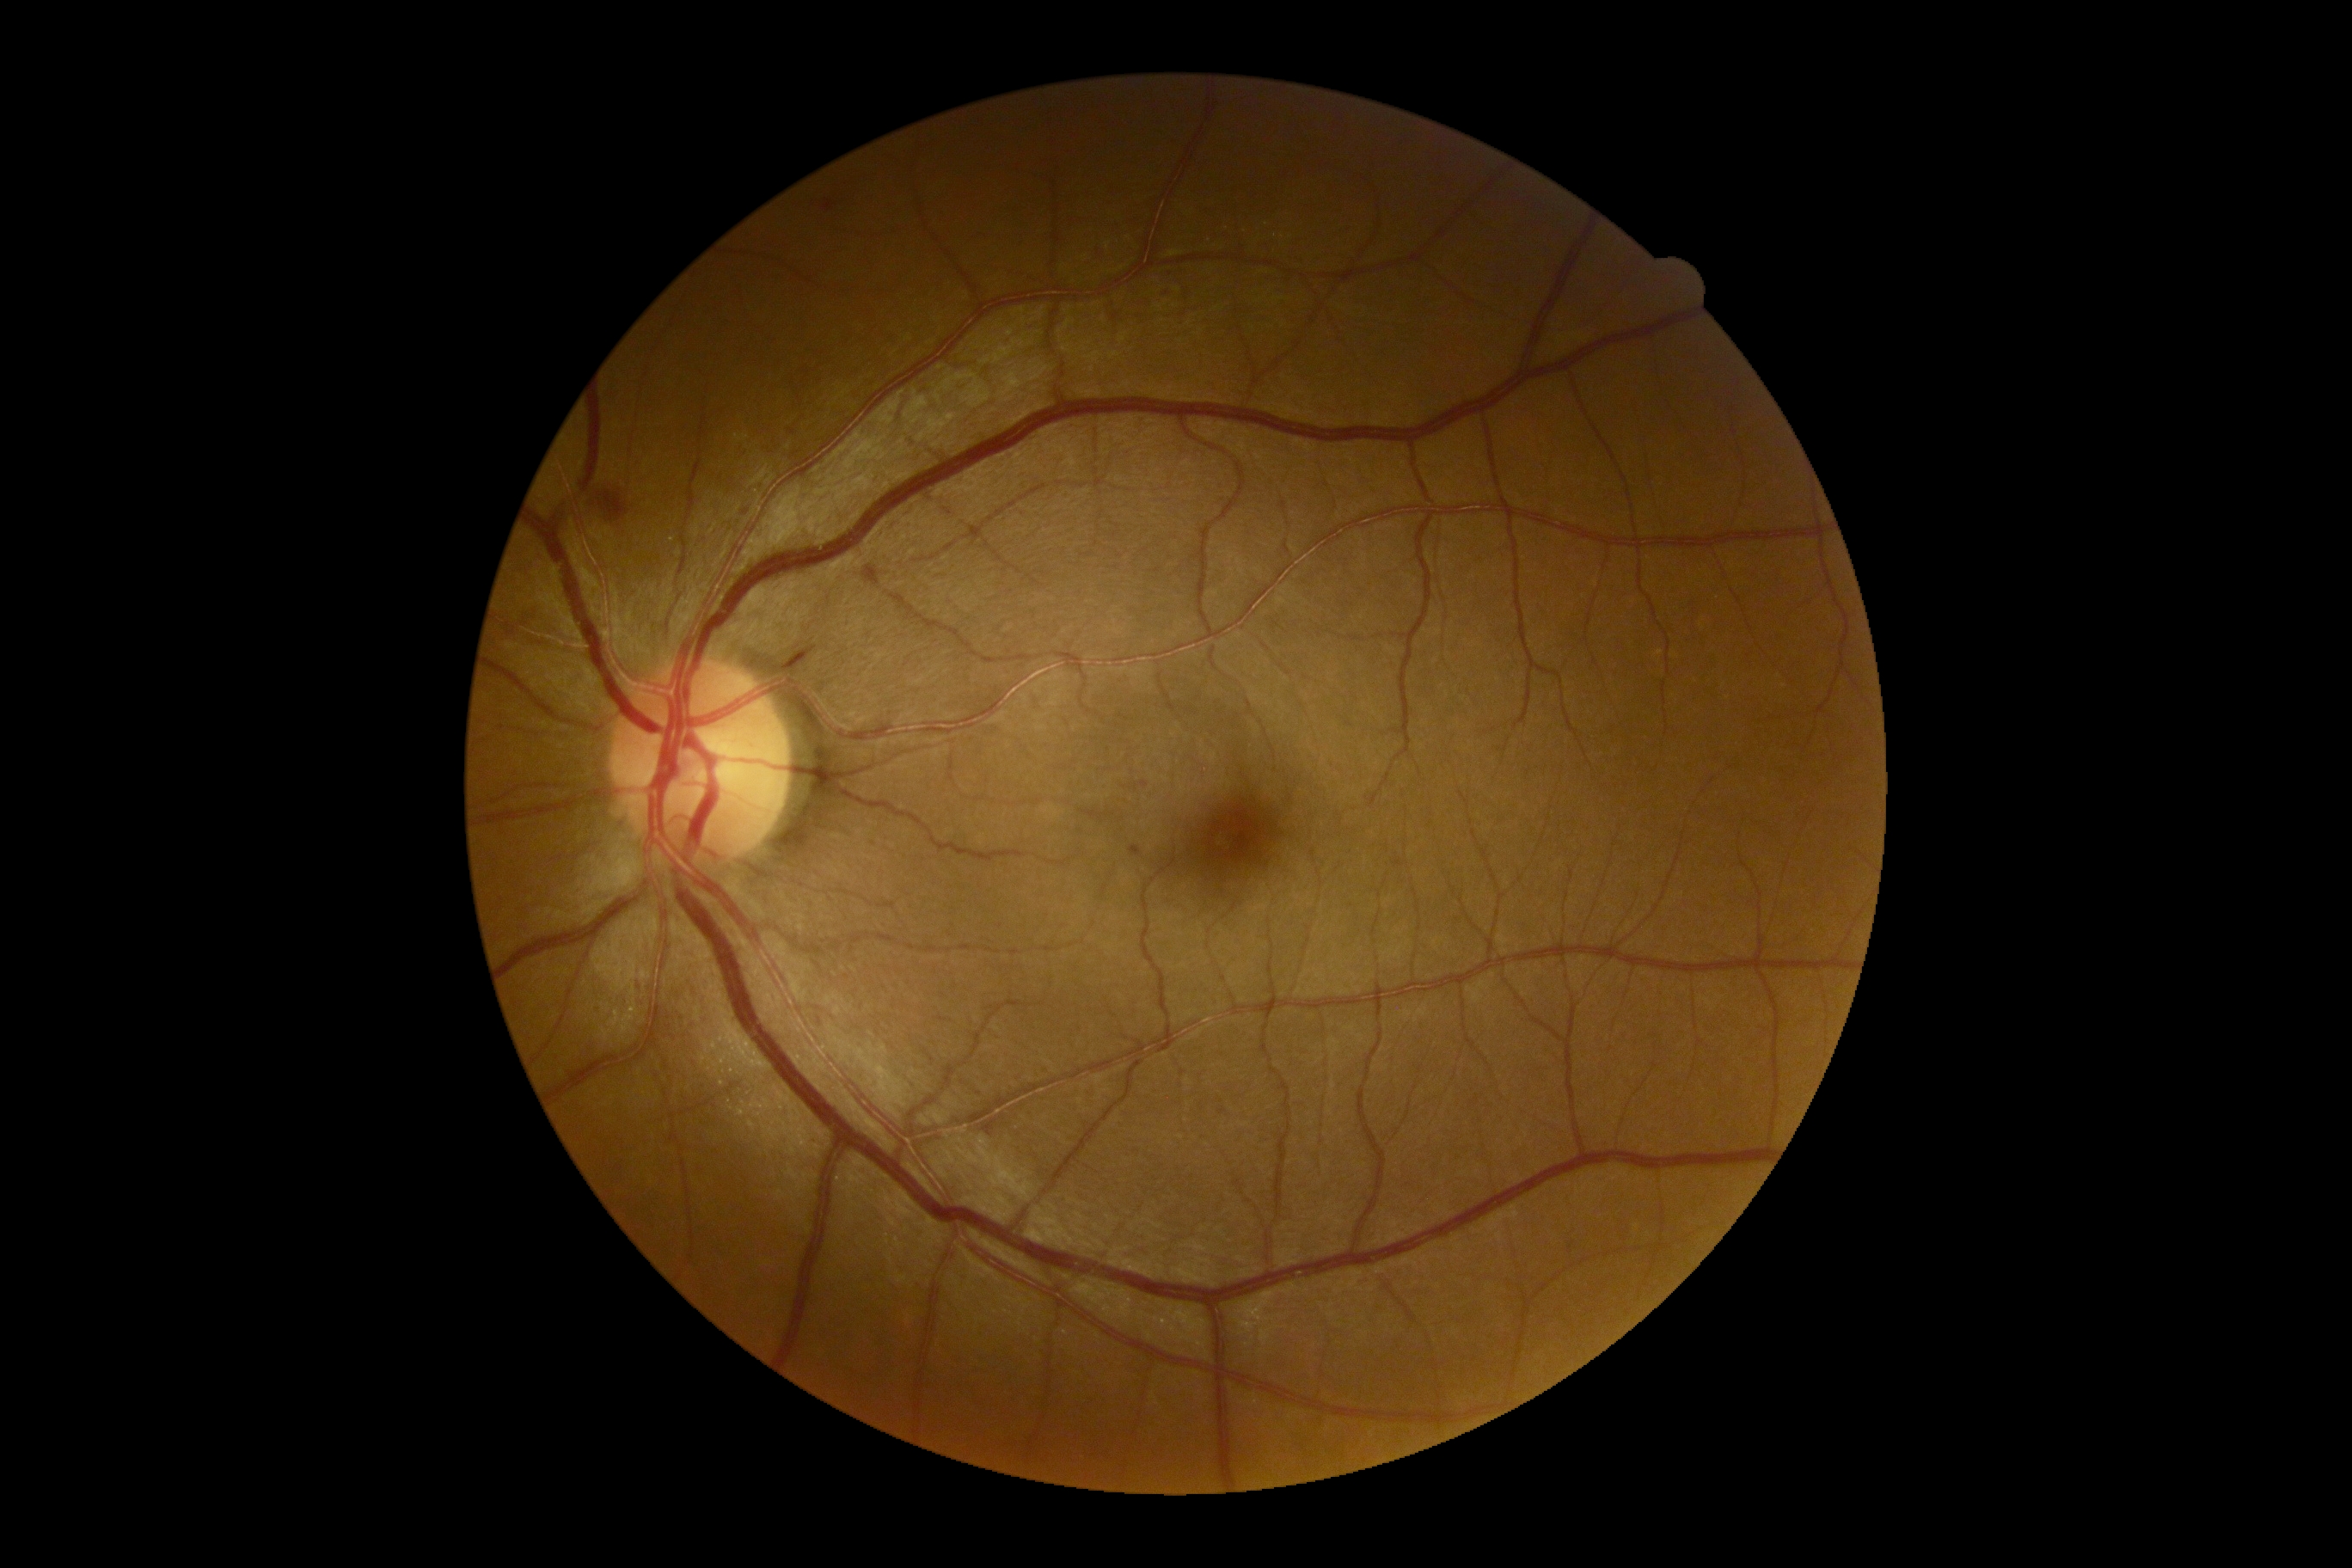

dr_grade: 2 (moderate NPDR)